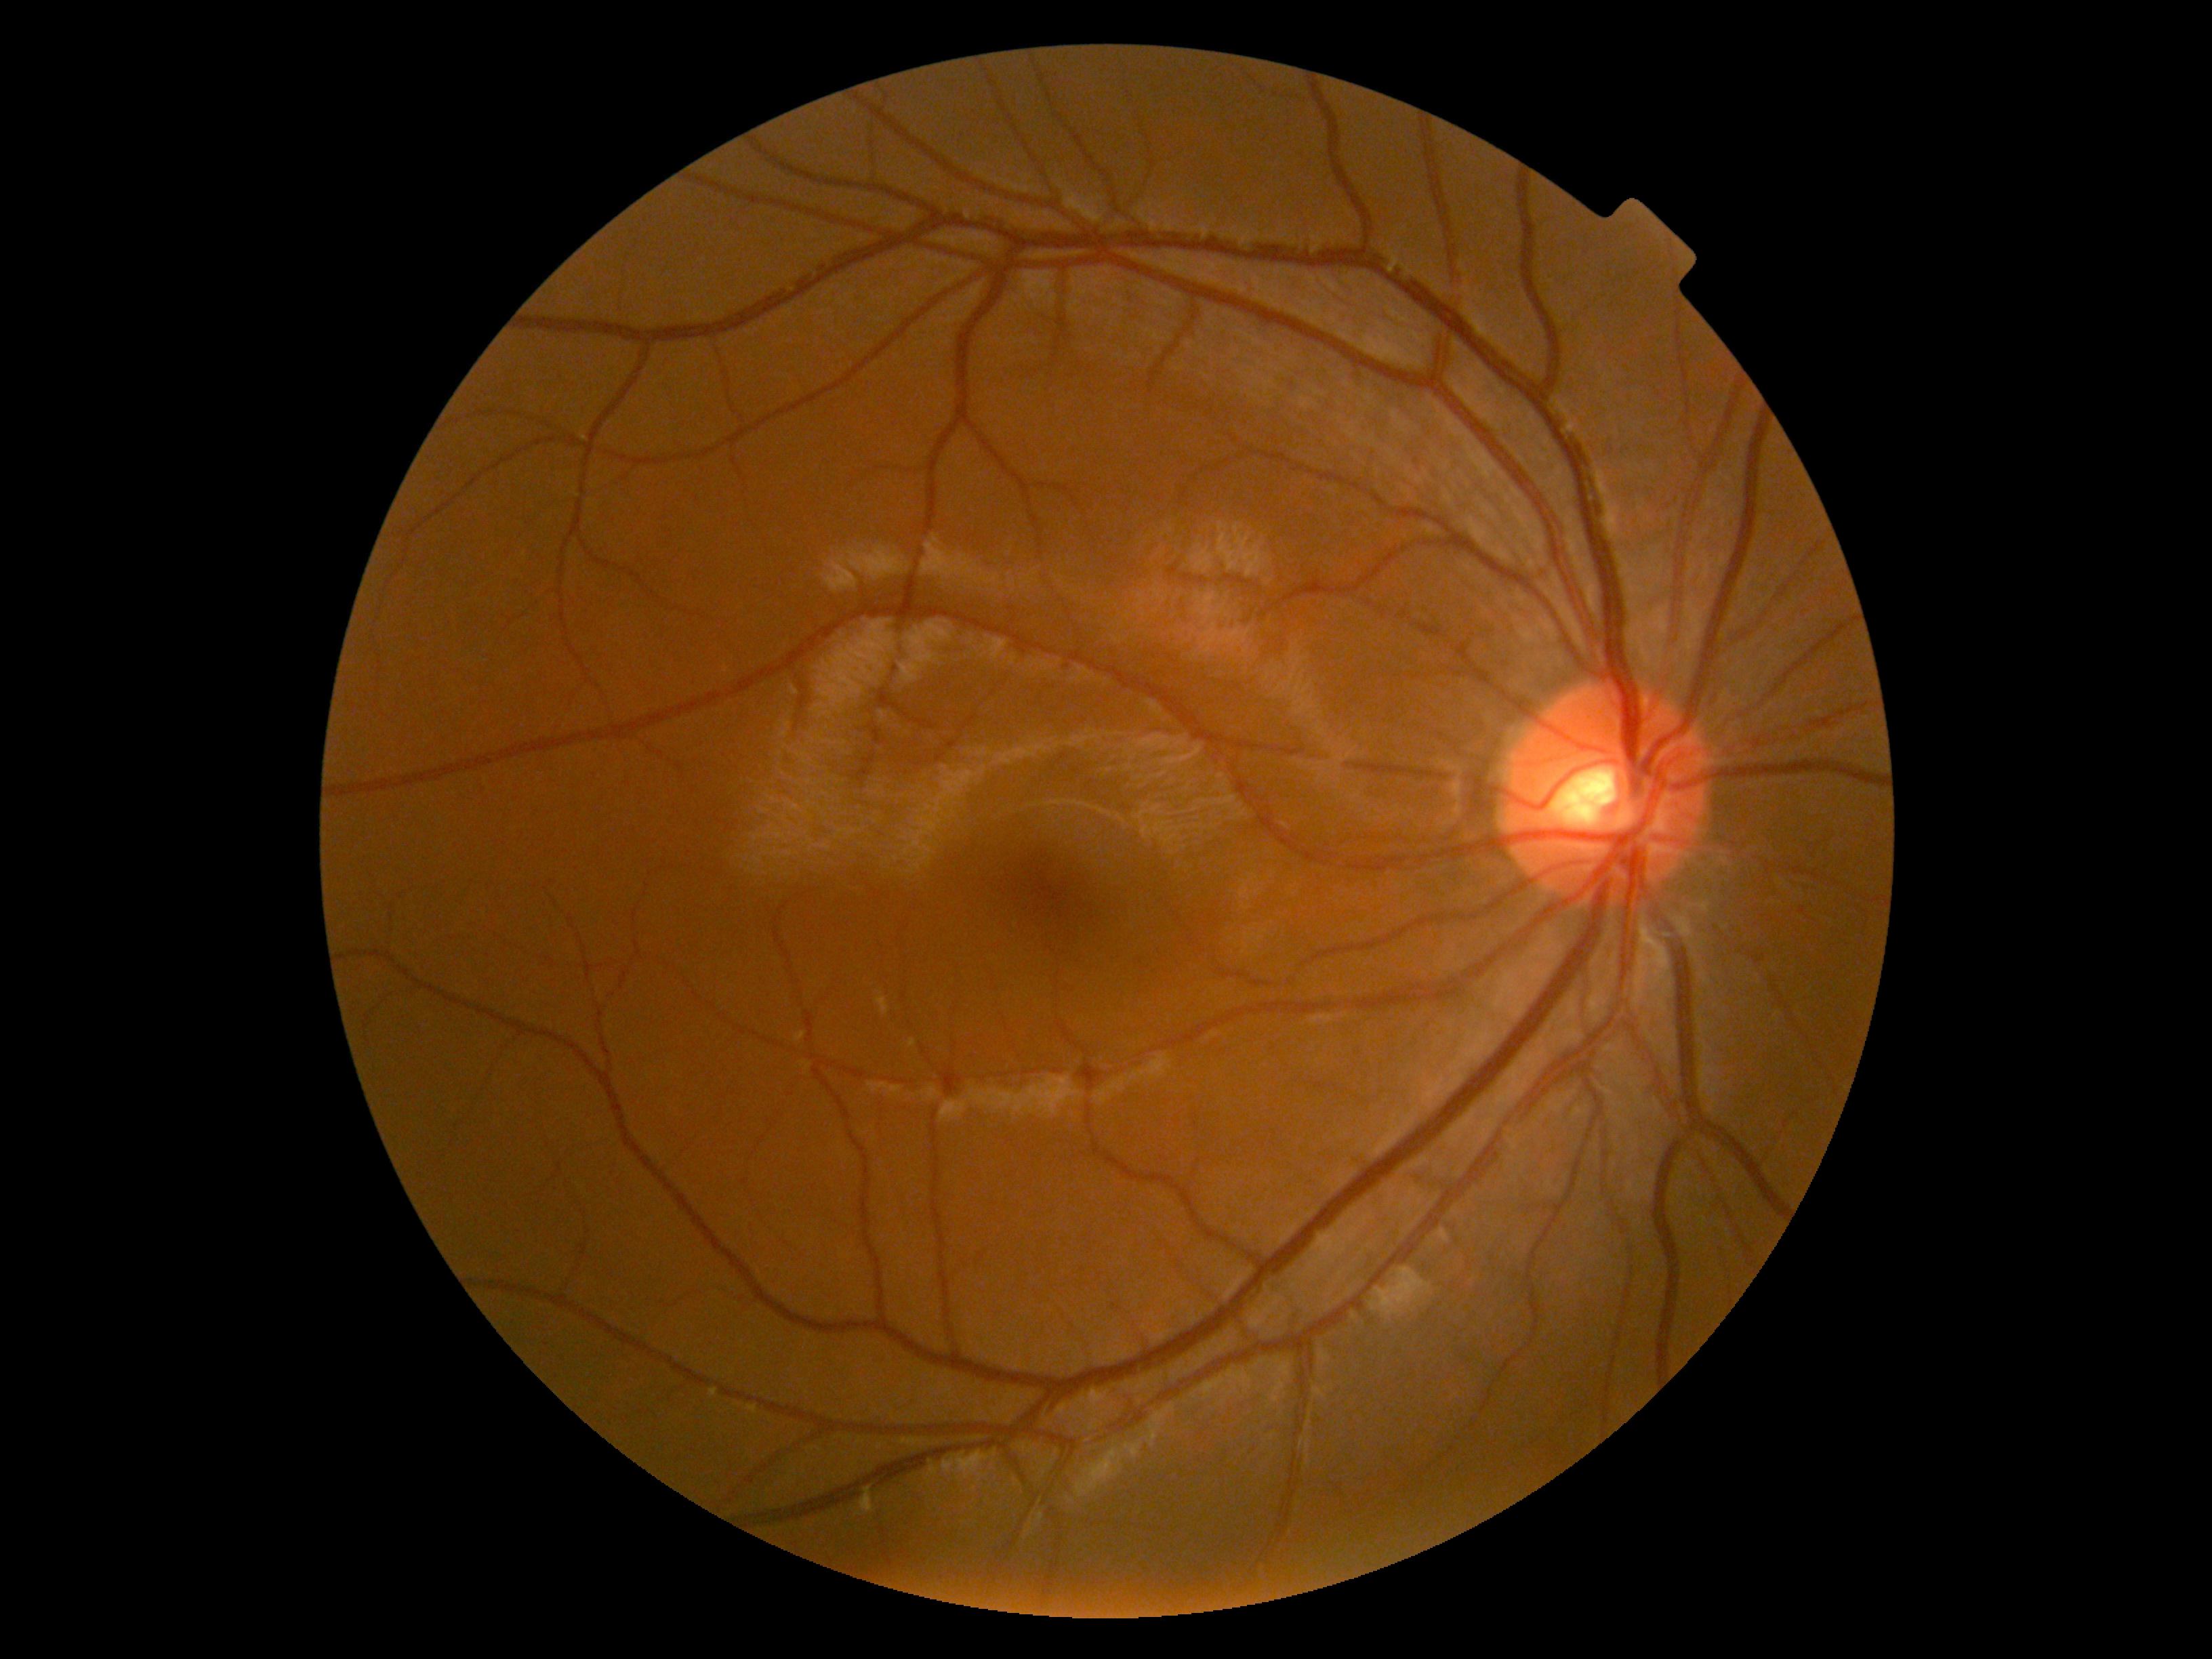 Diabetic retinopathy is grade 0 (no apparent retinopathy). No apparent diabetic retinopathy.